Camera: Phoenix ICON (100° FOV); pediatric wide-field fundus photograph:
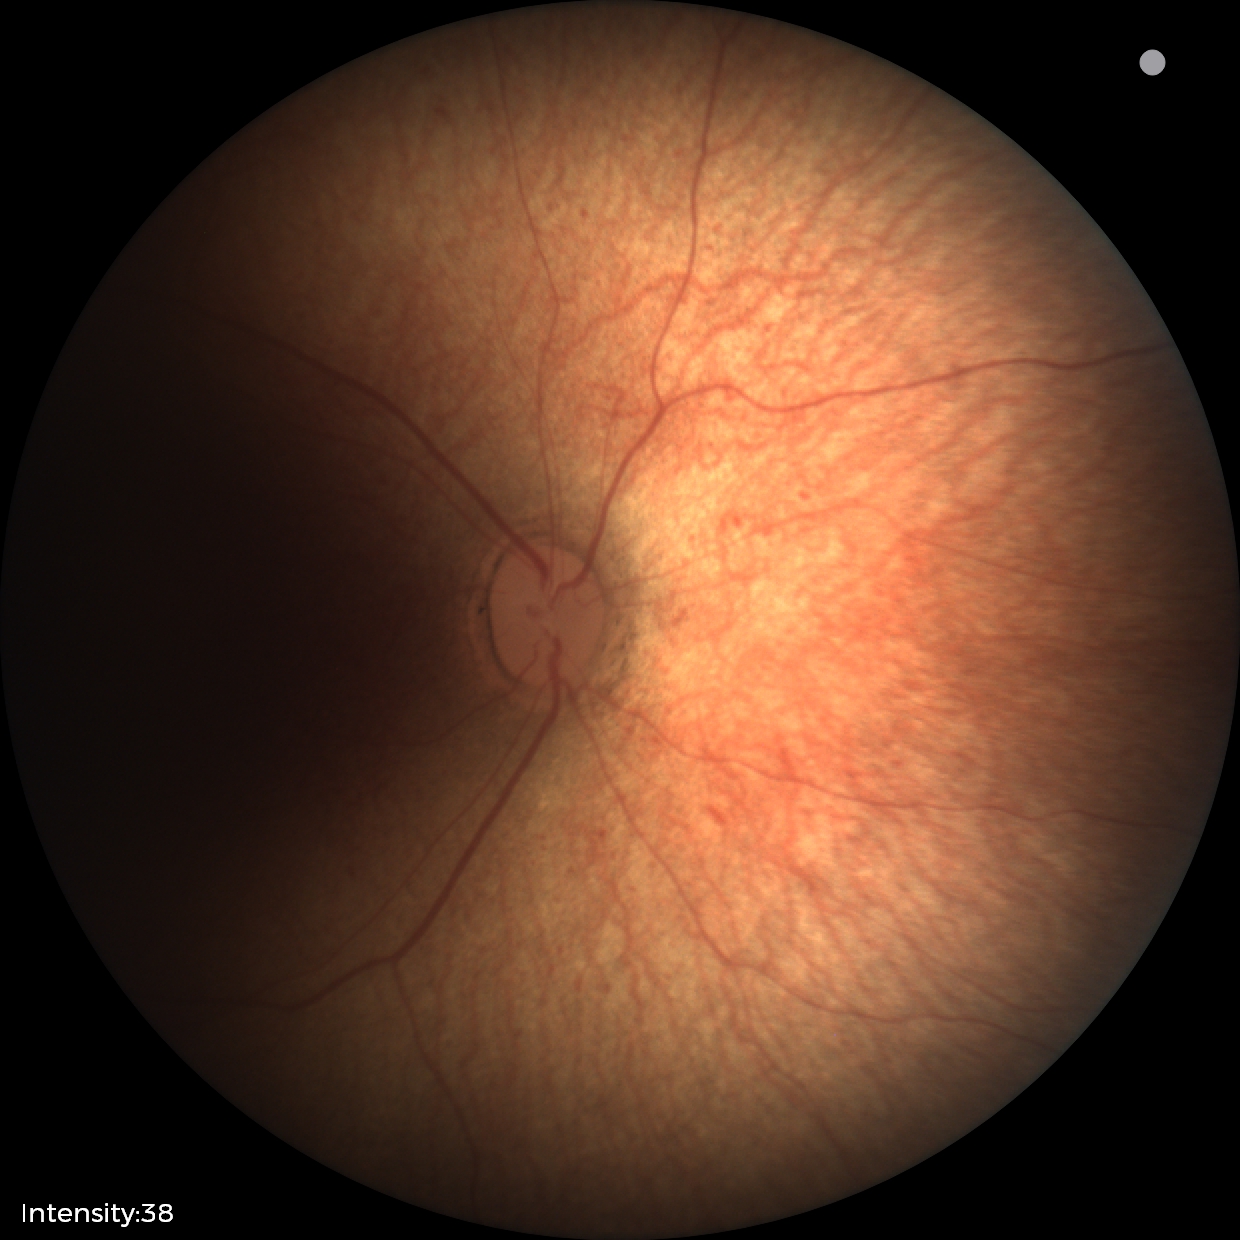
Impression: physiological finding.